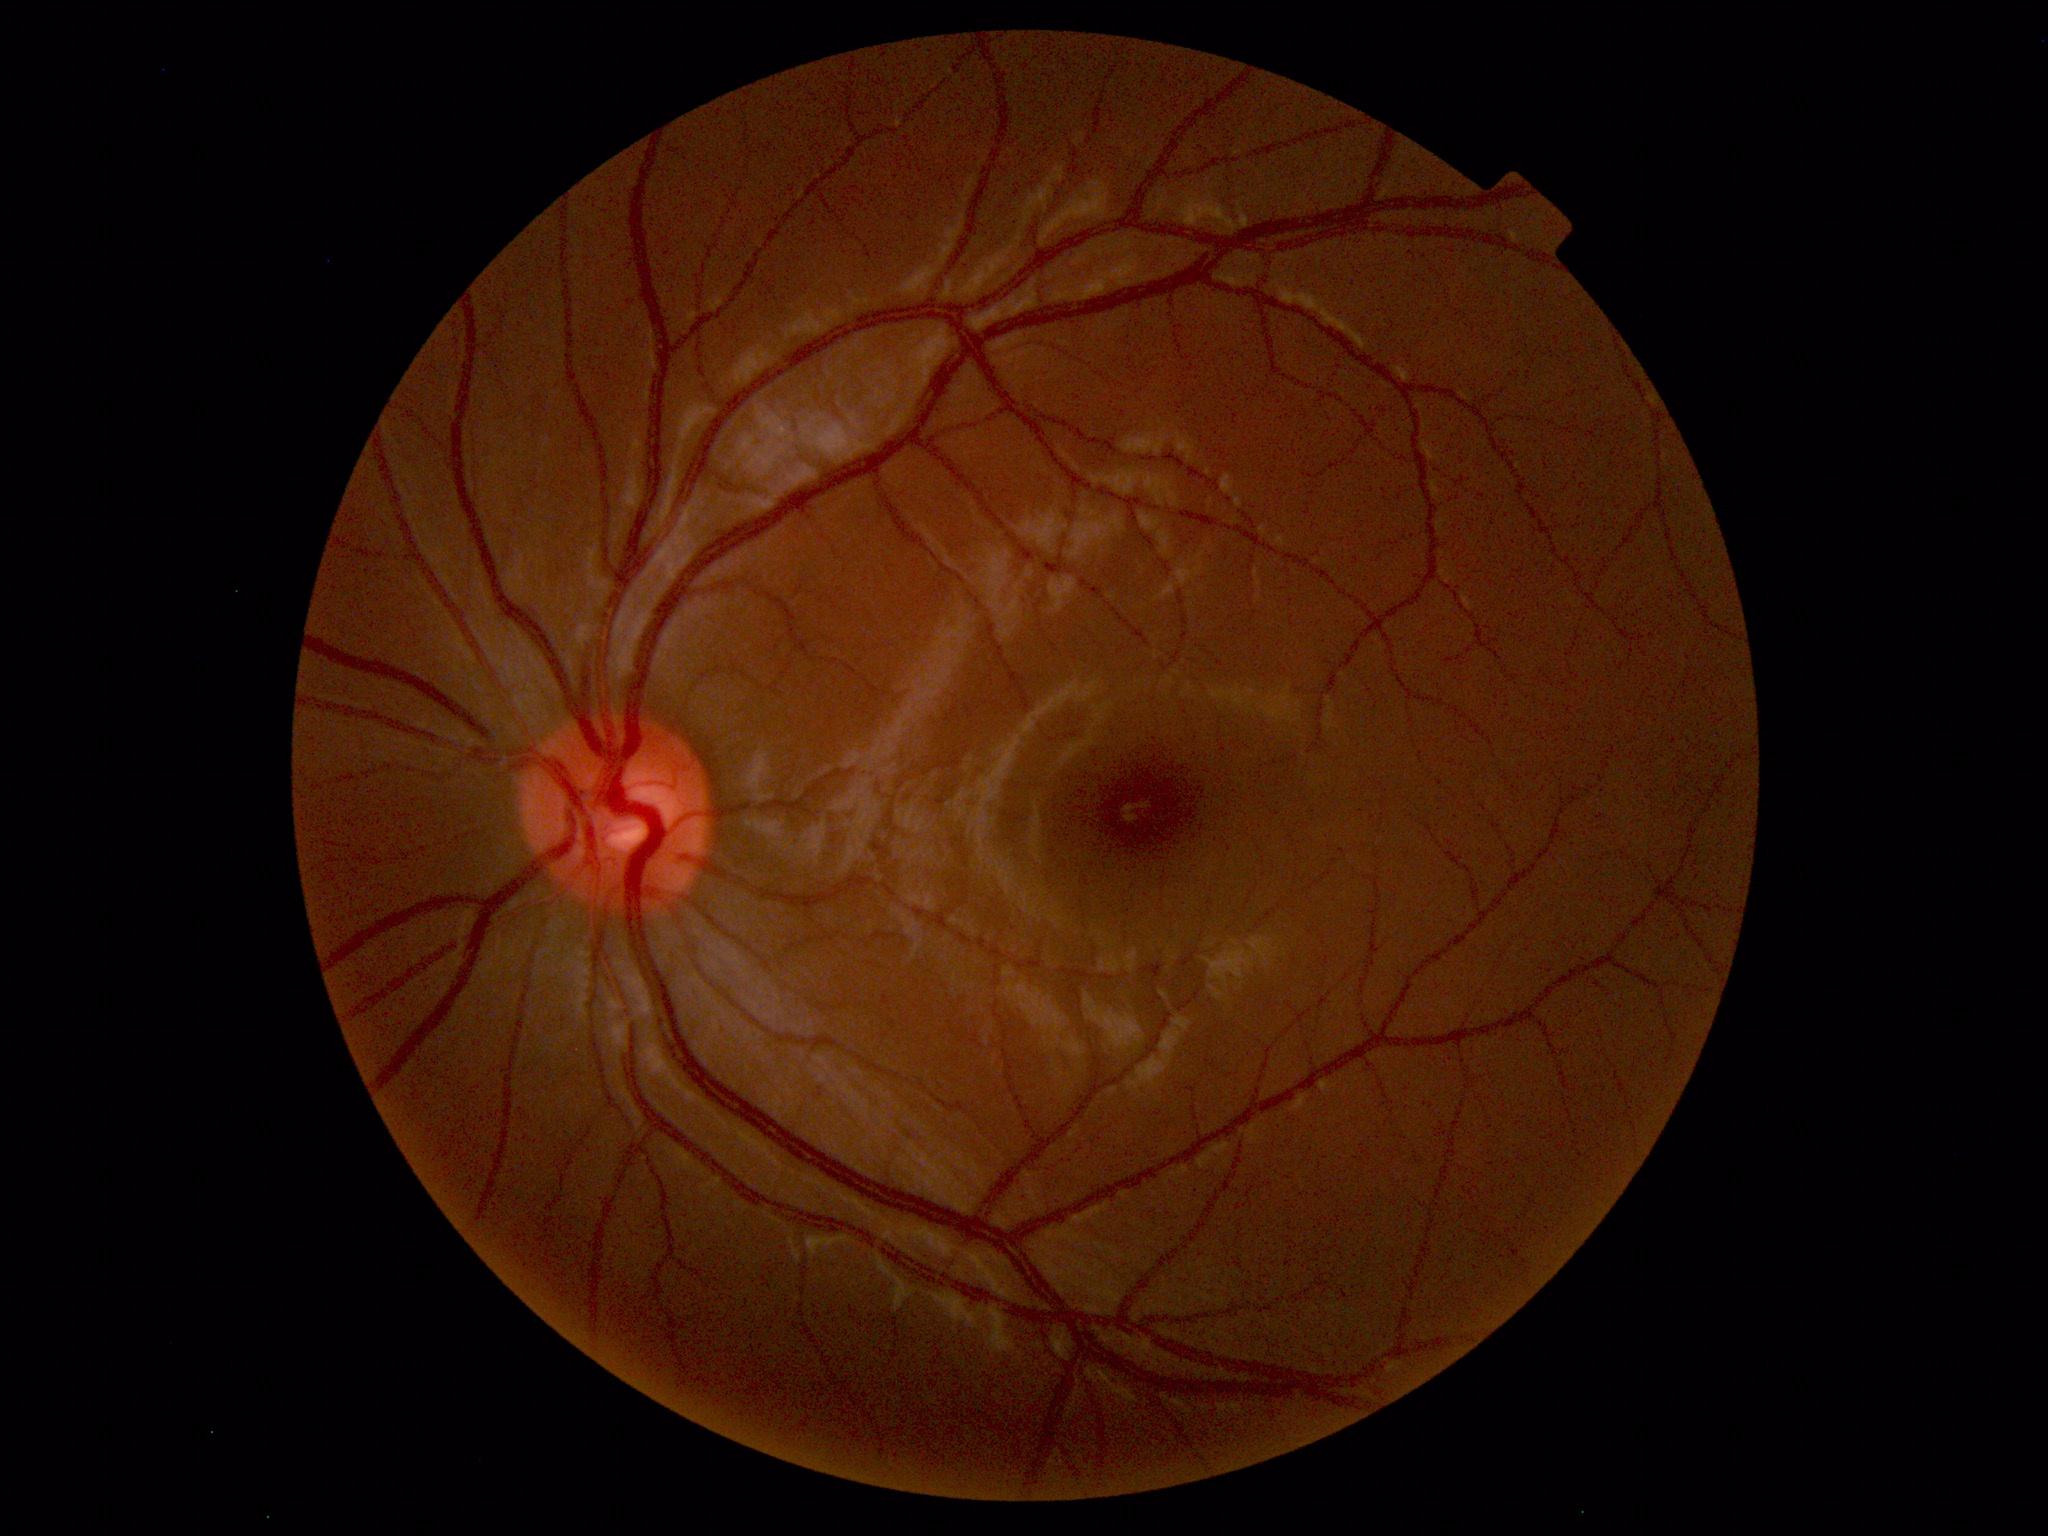

Fundus photograph within normal limits.